Without pupil dilation: 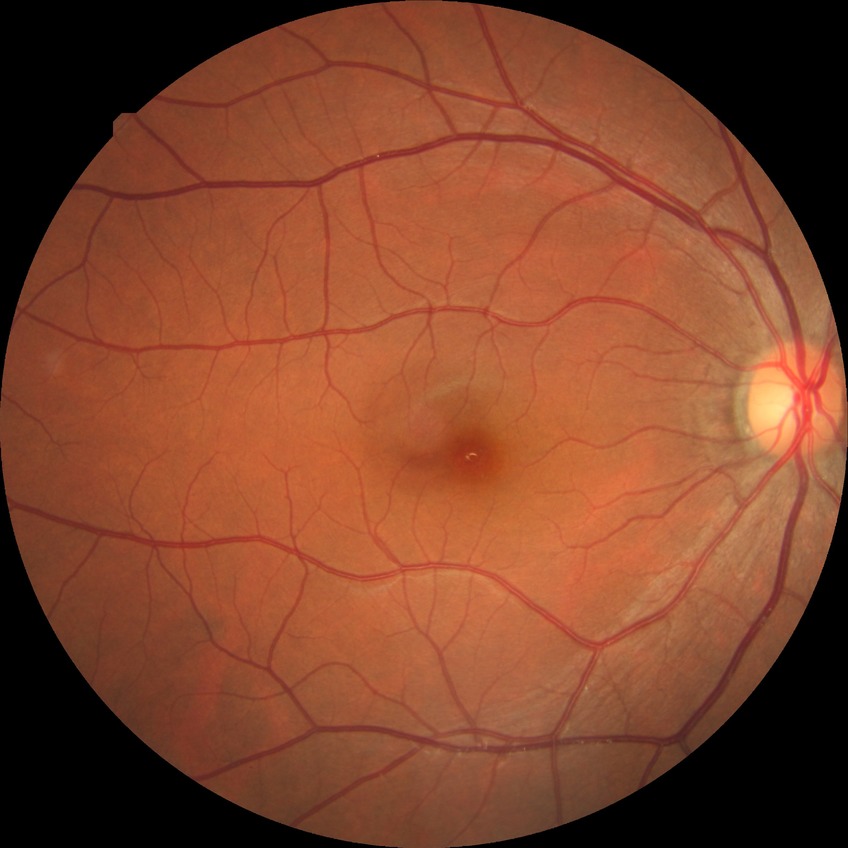
Findings:
- diabetic retinopathy grade — no diabetic retinopathy